Acquired on the Clarity RetCam 3 · wide-field fundus image from infant ROP screening
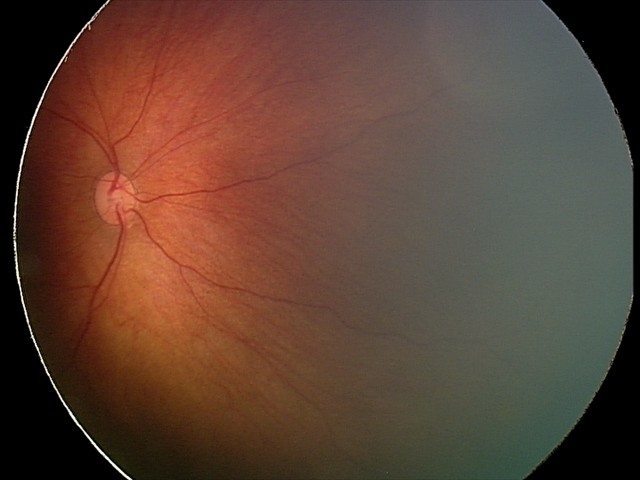 Screening series with retinal hemorrhages.